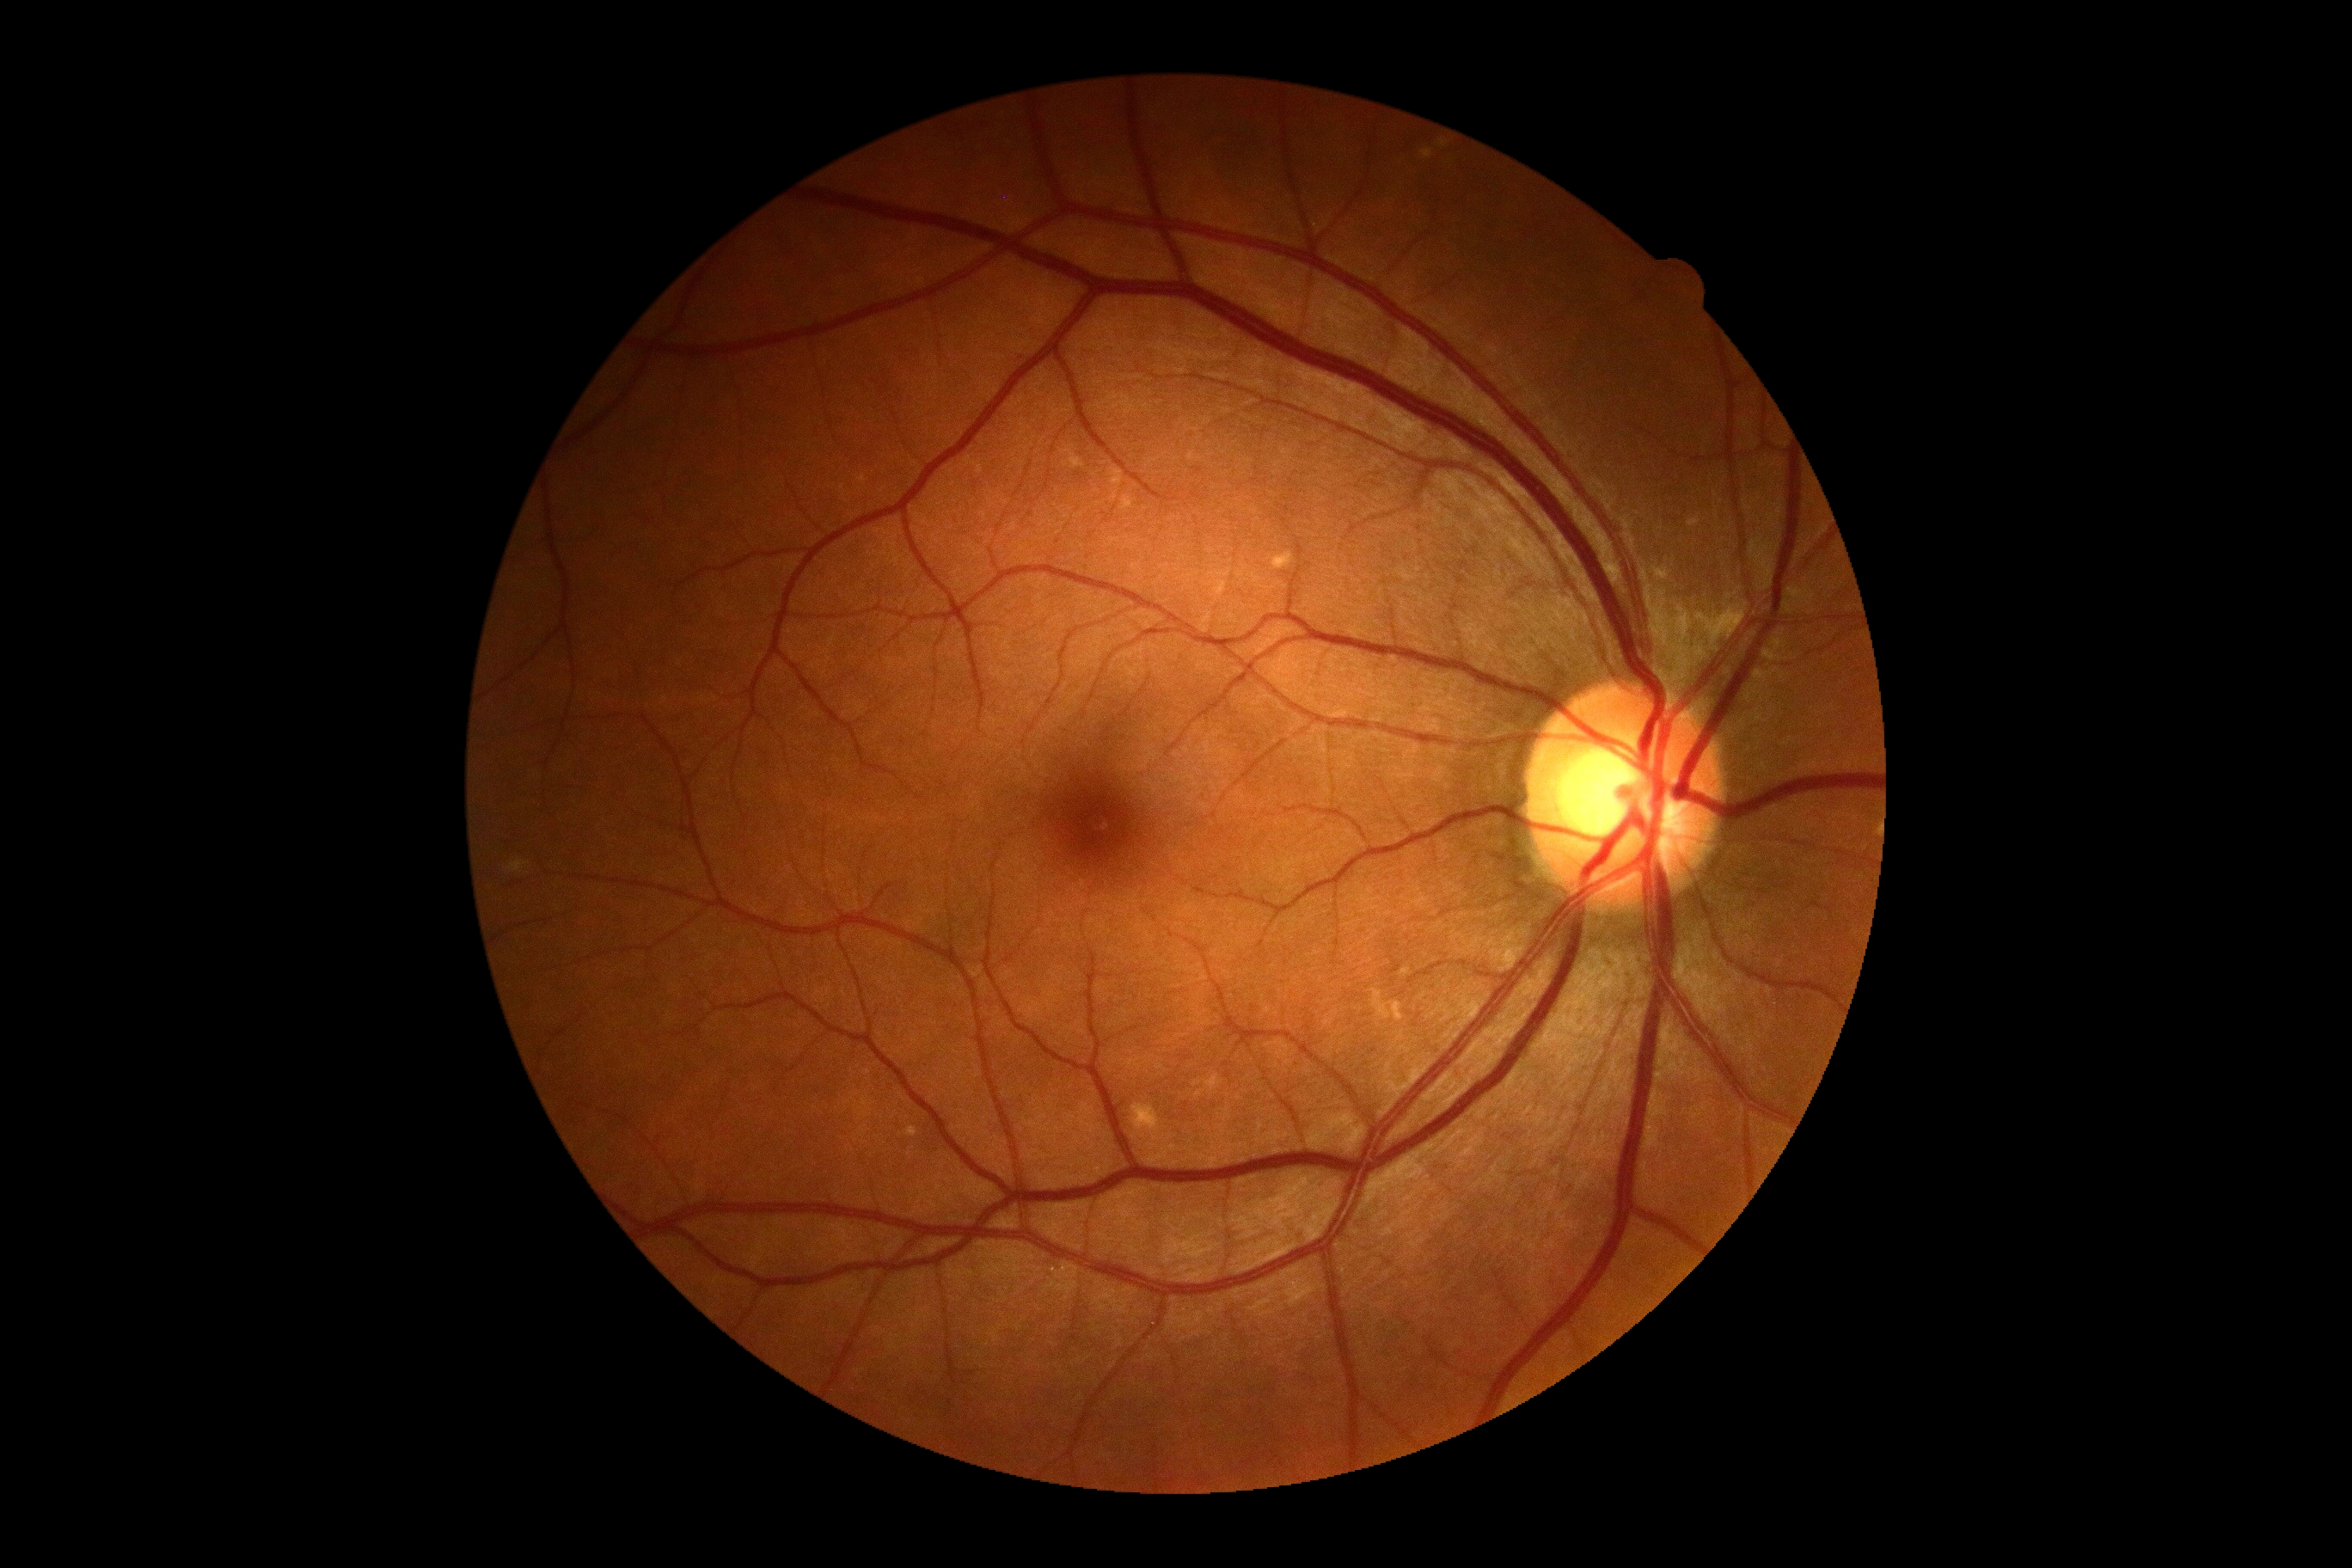
diabetic retinopathy grade: 0.